741 by 713 pixels; color fundus image; 45-degree field of view:
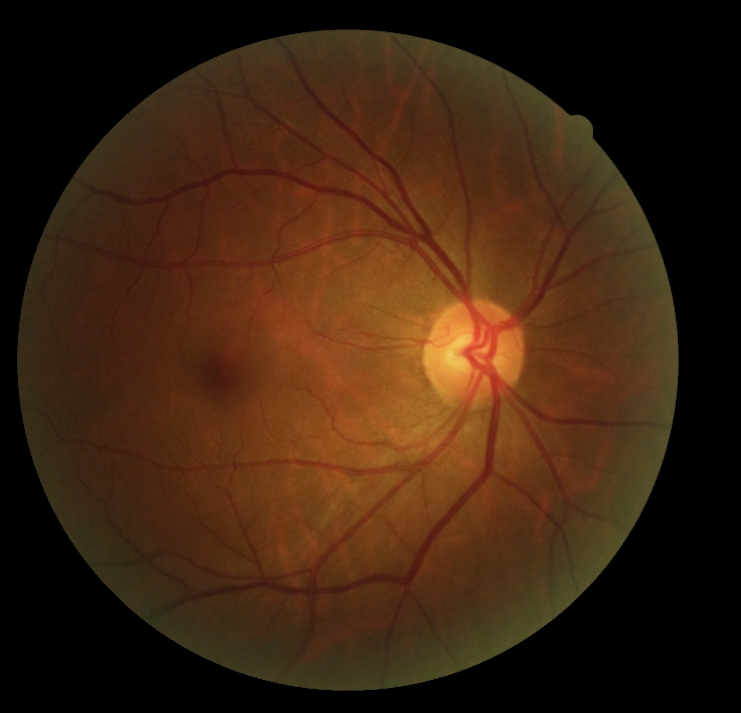

DR grade is 0/4.